FOV: 45 degrees; image size 2352x1568
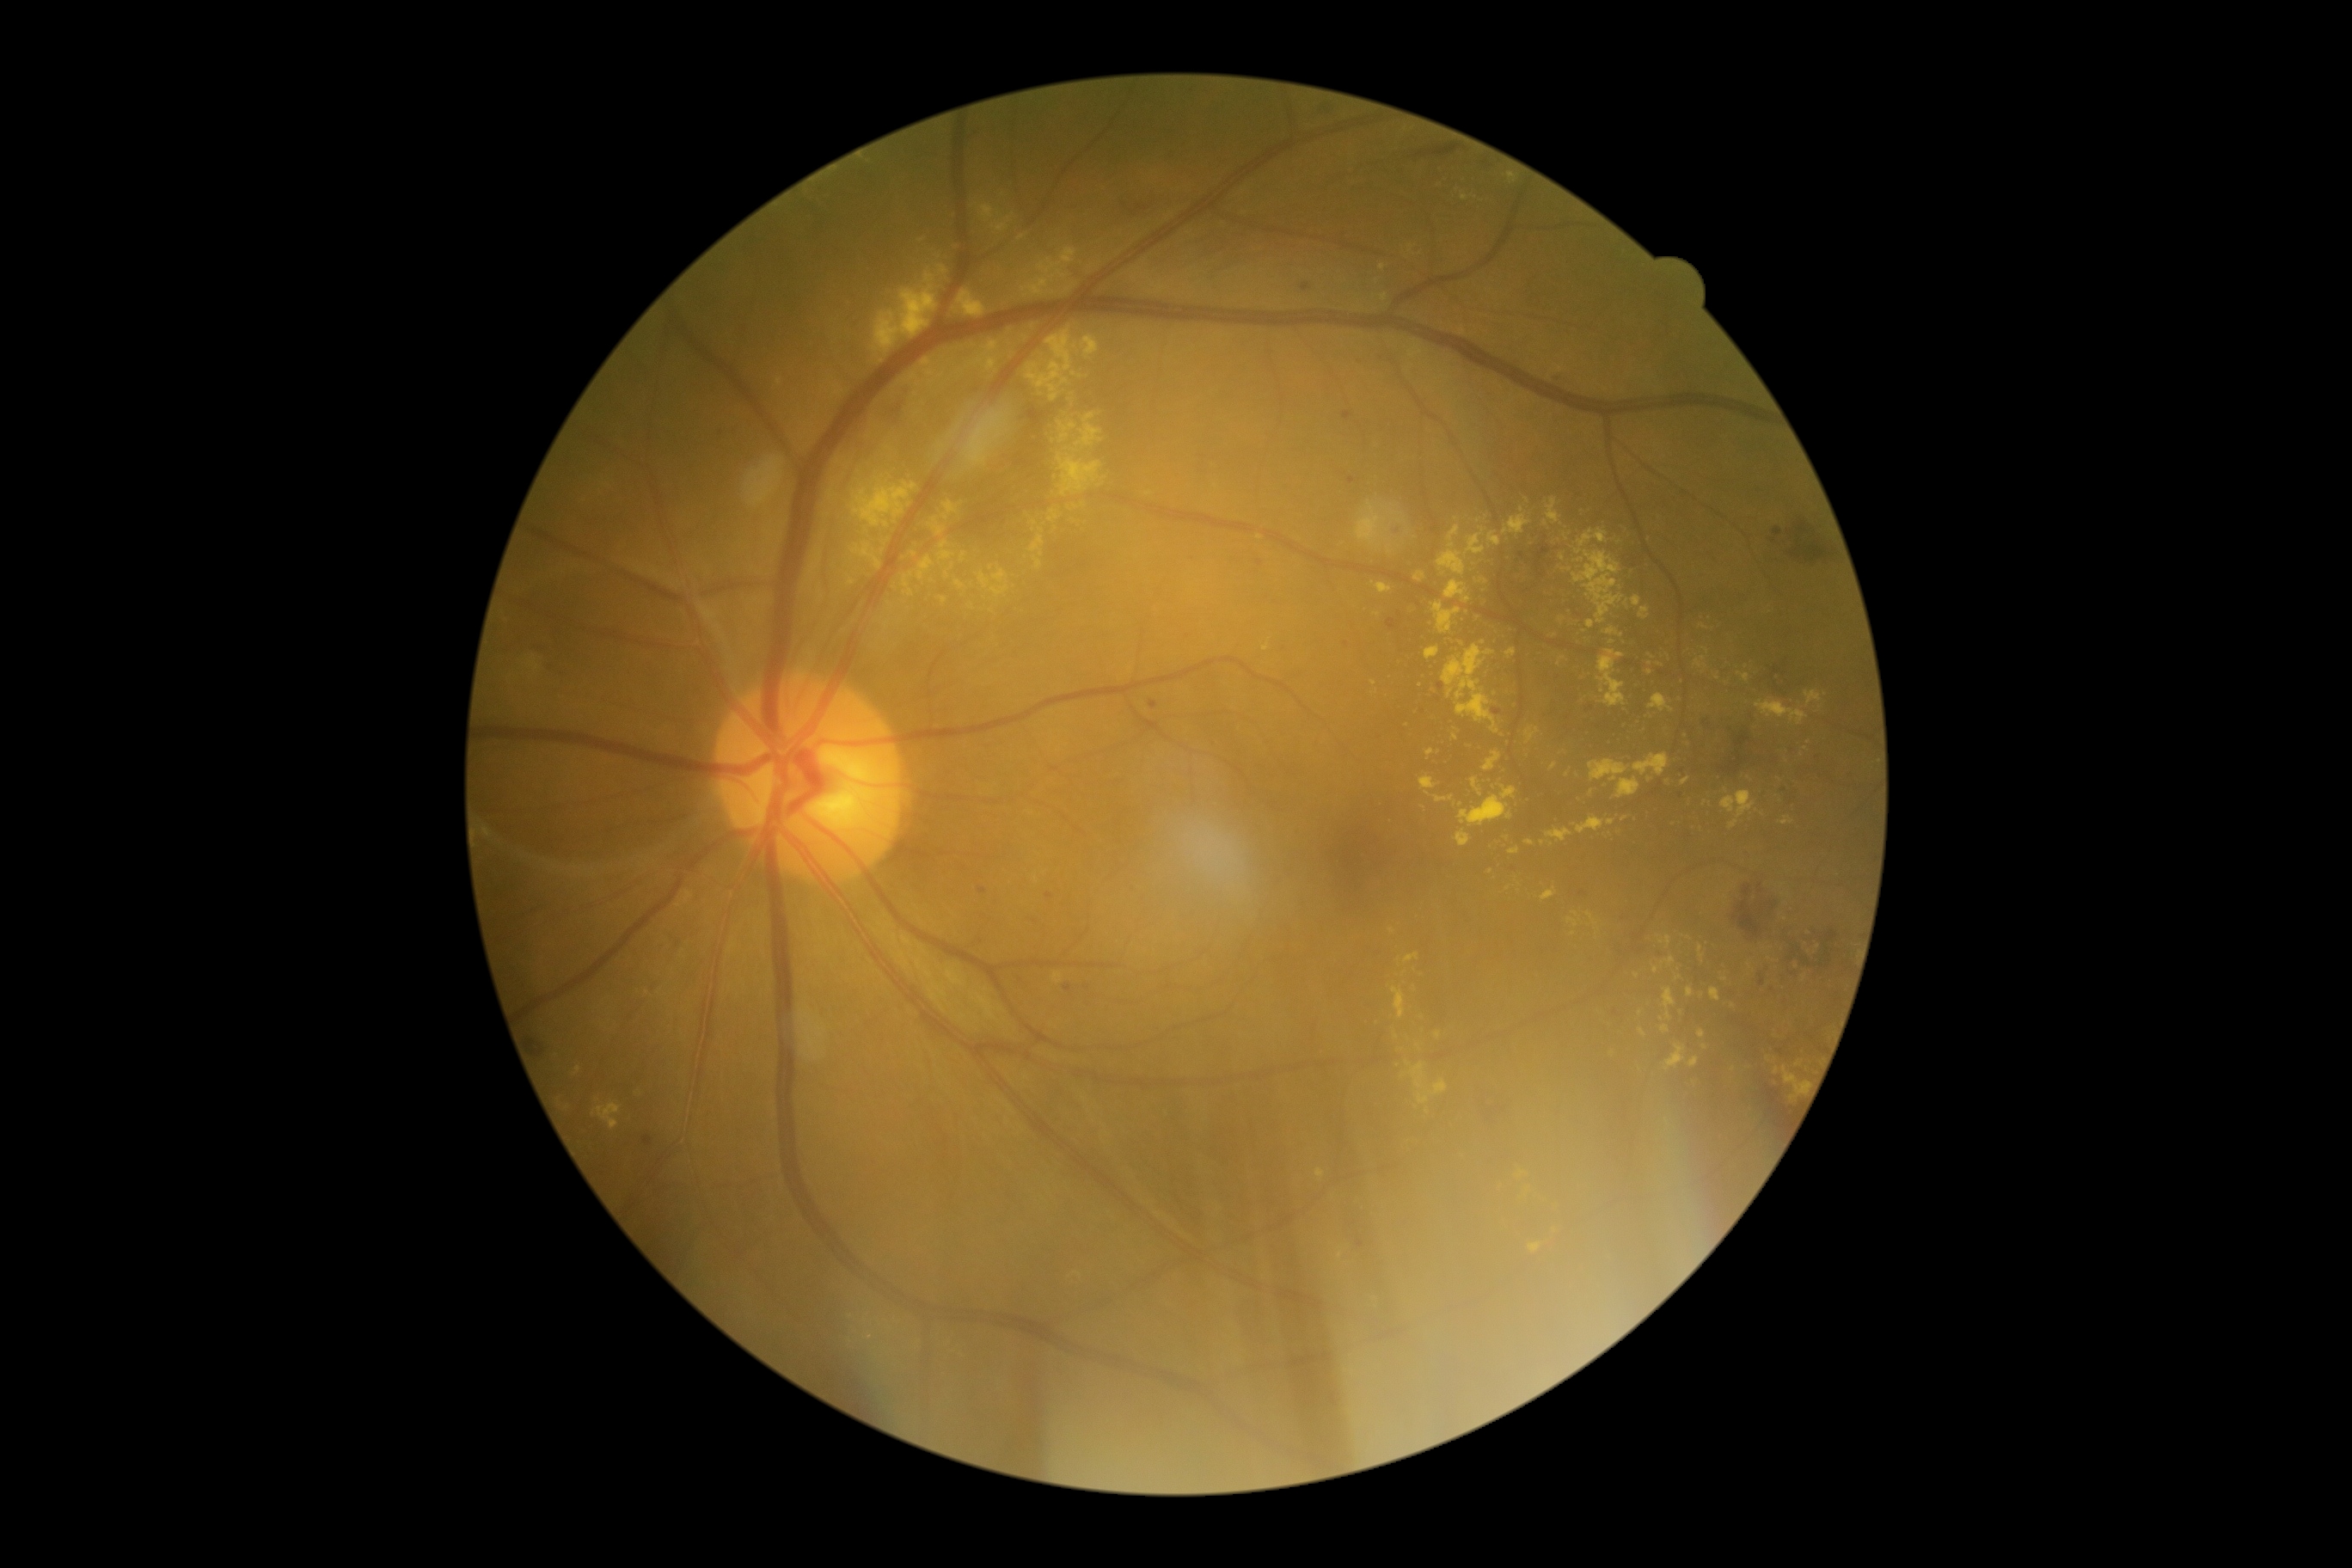
{"partial": true, "dr_grade": 2, "dr_grade_name": "moderate NPDR", "lesions": {"he": [[1328, 1392, 1338, 1407], [1758, 907, 1765, 917], [1763, 666, 1787, 697], [1787, 520, 1834, 565], [530, 644, 549, 659], [1827, 929, 1837, 943], [1773, 529, 1784, 537], [548, 661, 565, 675], [1416, 145, 1461, 157], [529, 1038, 546, 1058], [1514, 537, 1548, 584], [1483, 161, 1491, 168]], "he_small": [[1773, 540], [1775, 761], [1794, 953]], "ex": [[1485, 750, 1502, 771], [1550, 763, 1557, 771], [873, 273, 938, 353], [1588, 761, 1629, 781], [995, 219, 1012, 233], [1356, 501, 1387, 549], [1426, 646, 1440, 659], [1617, 778, 1641, 799], [1689, 1057, 1700, 1067], [1435, 797, 1454, 804], [1426, 749, 1435, 757]], "ex_small": [[1438, 1034], [1149, 493], [1640, 1012], [1421, 685], [839, 462], [919, 385], [1649, 663], [883, 552], [1567, 538]]}}